Retinal fundus photograph — 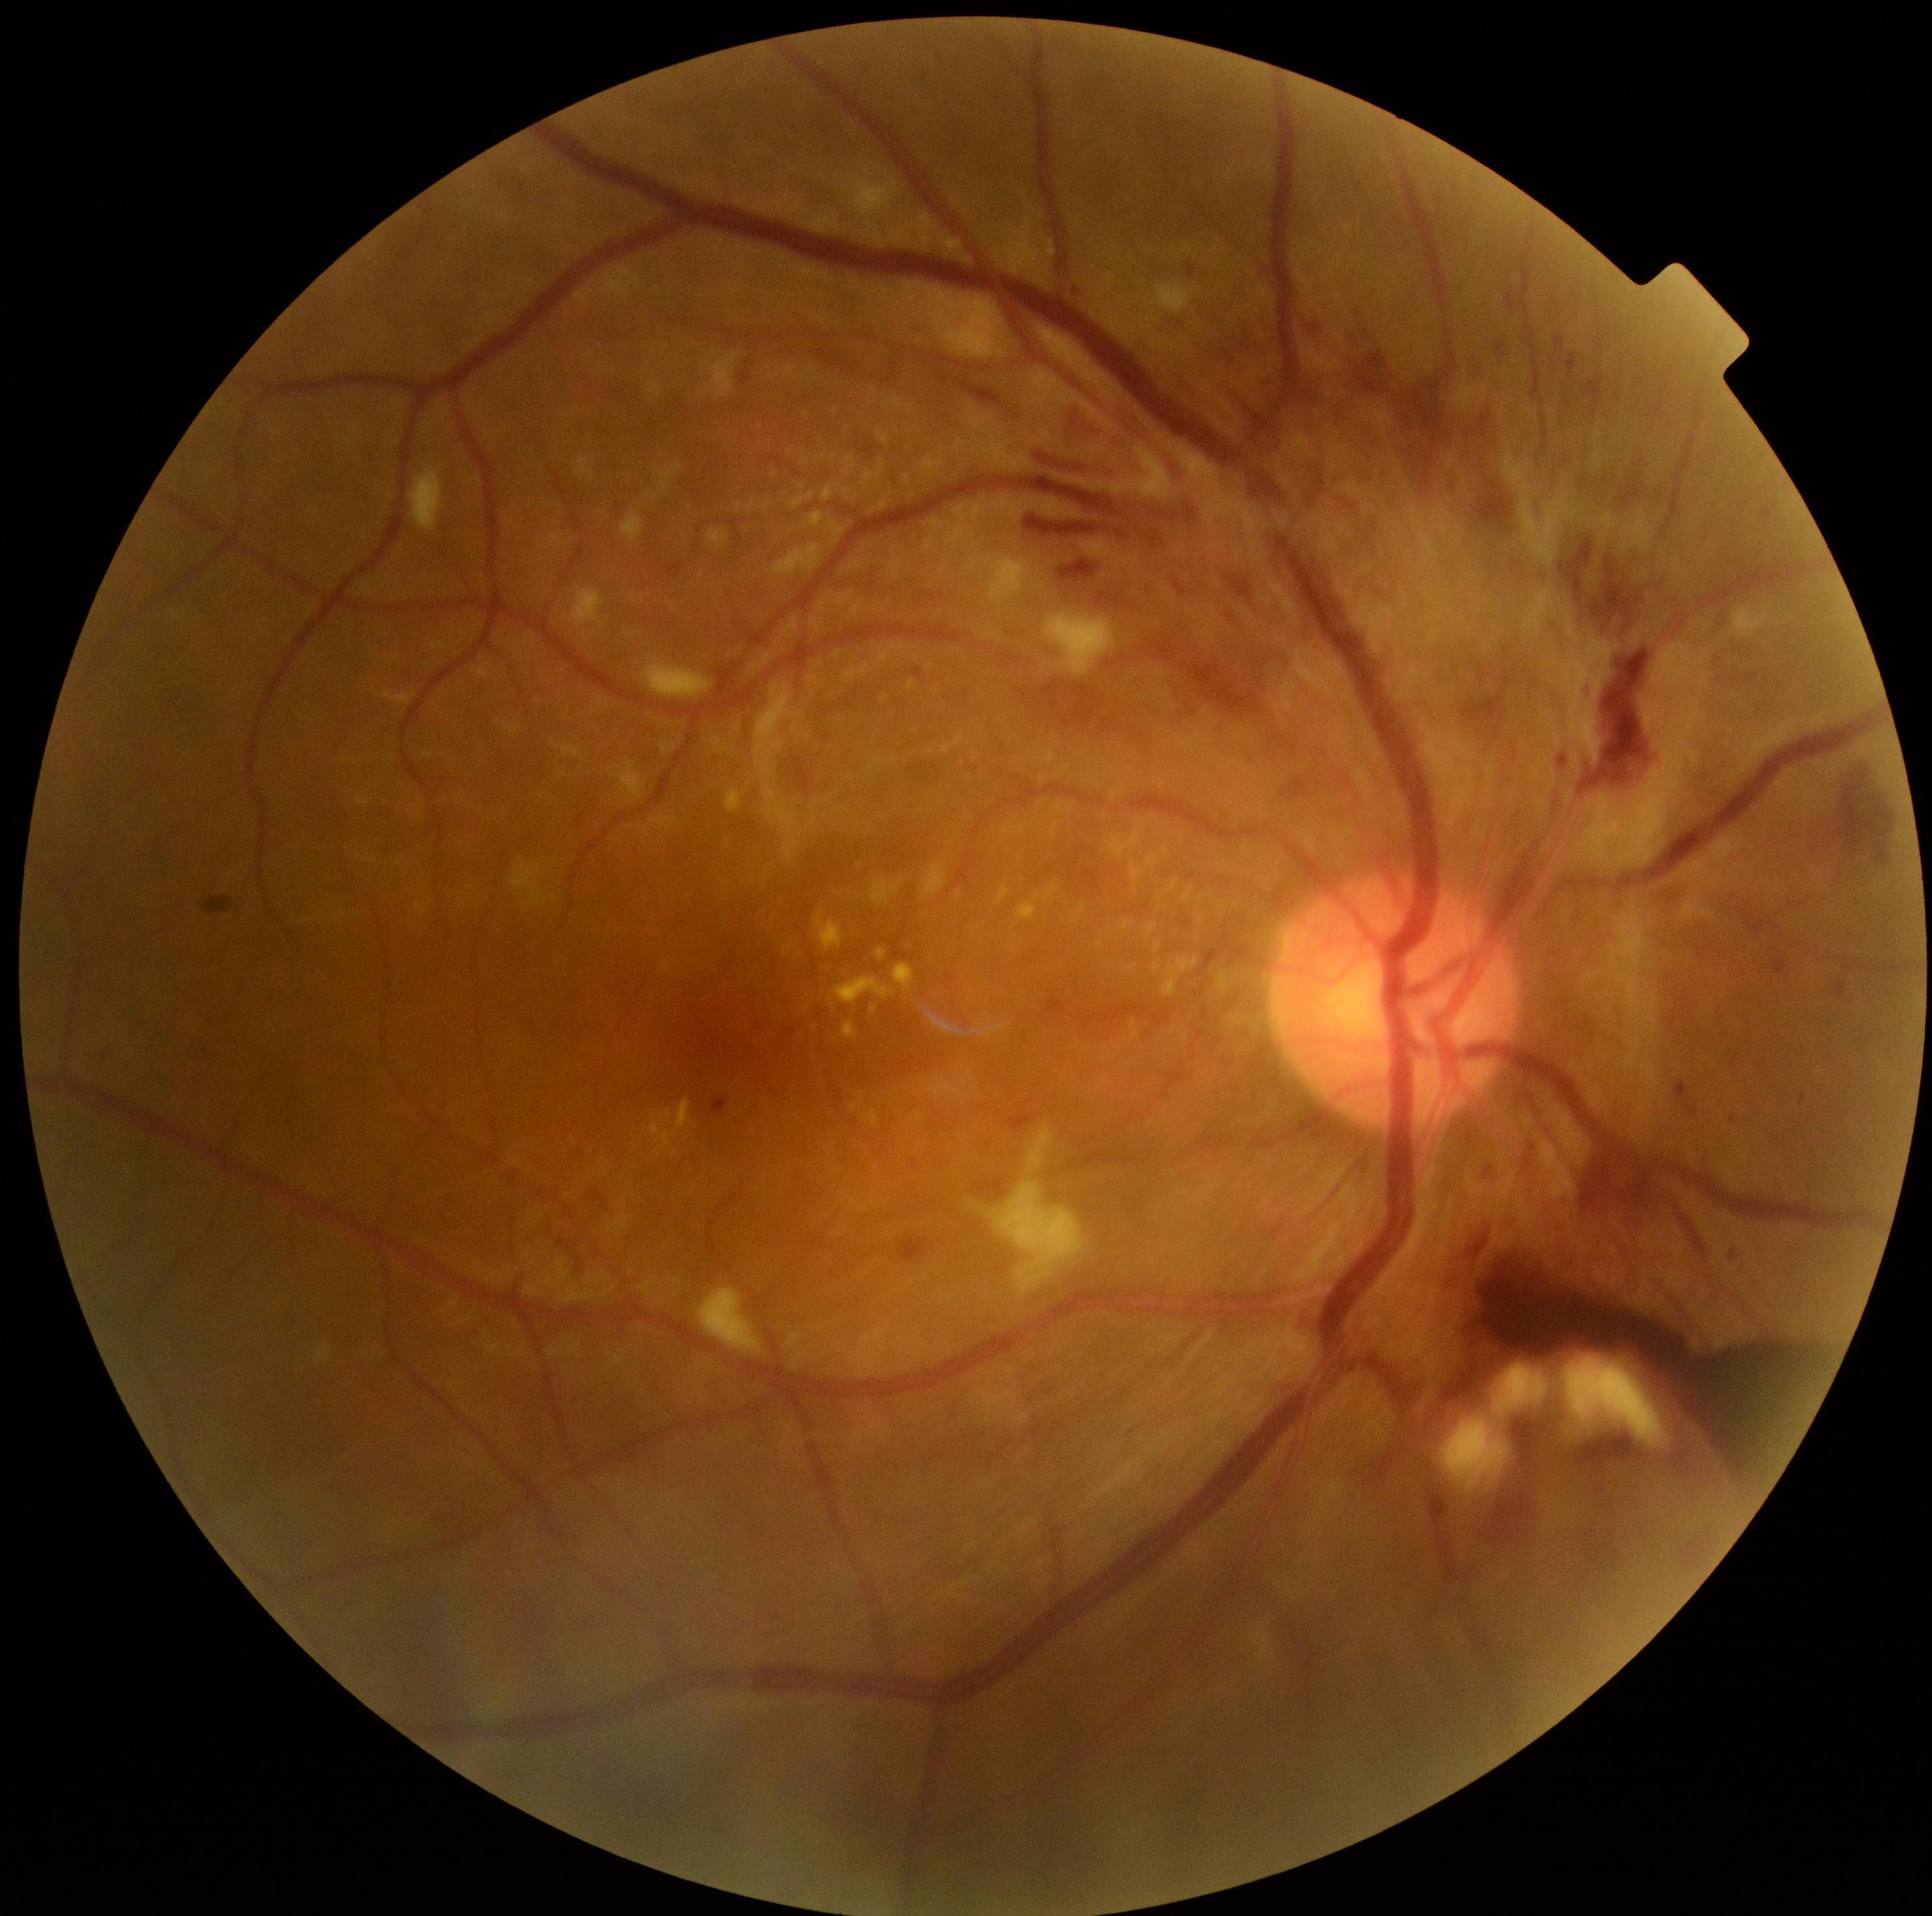

diabetic retinopathy (DR)=grade 4 — neovascularization and/or vitreous/pre-retinal hemorrhage.